Infant wide-field retinal image.
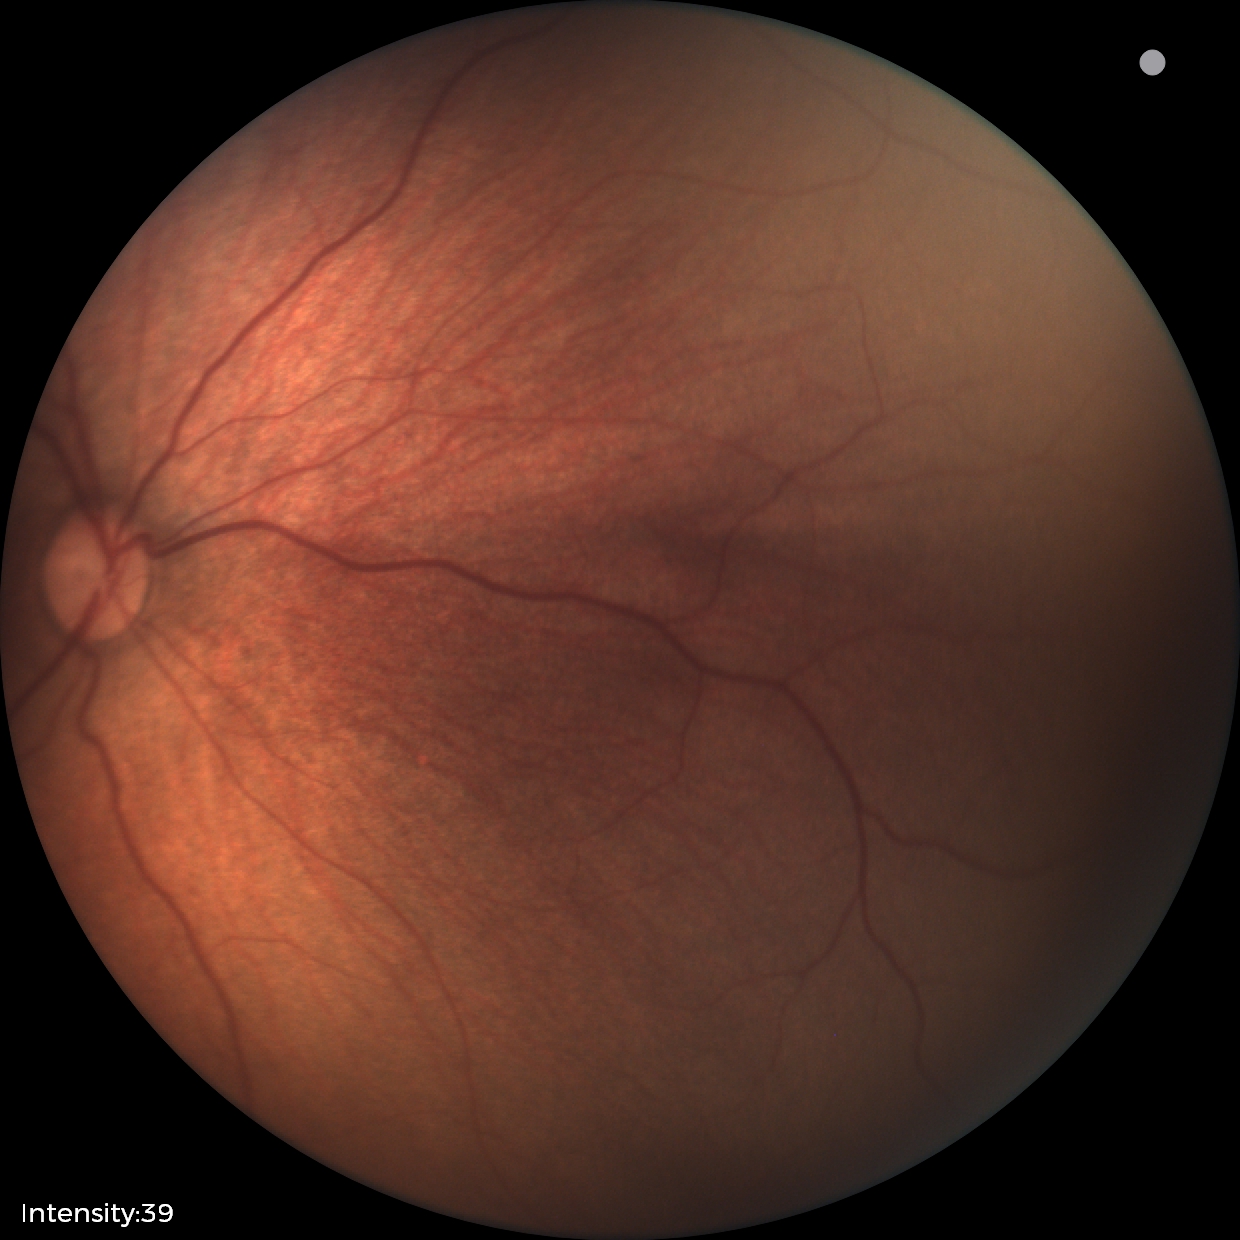
Screening examination with no abnormal retinal findings.